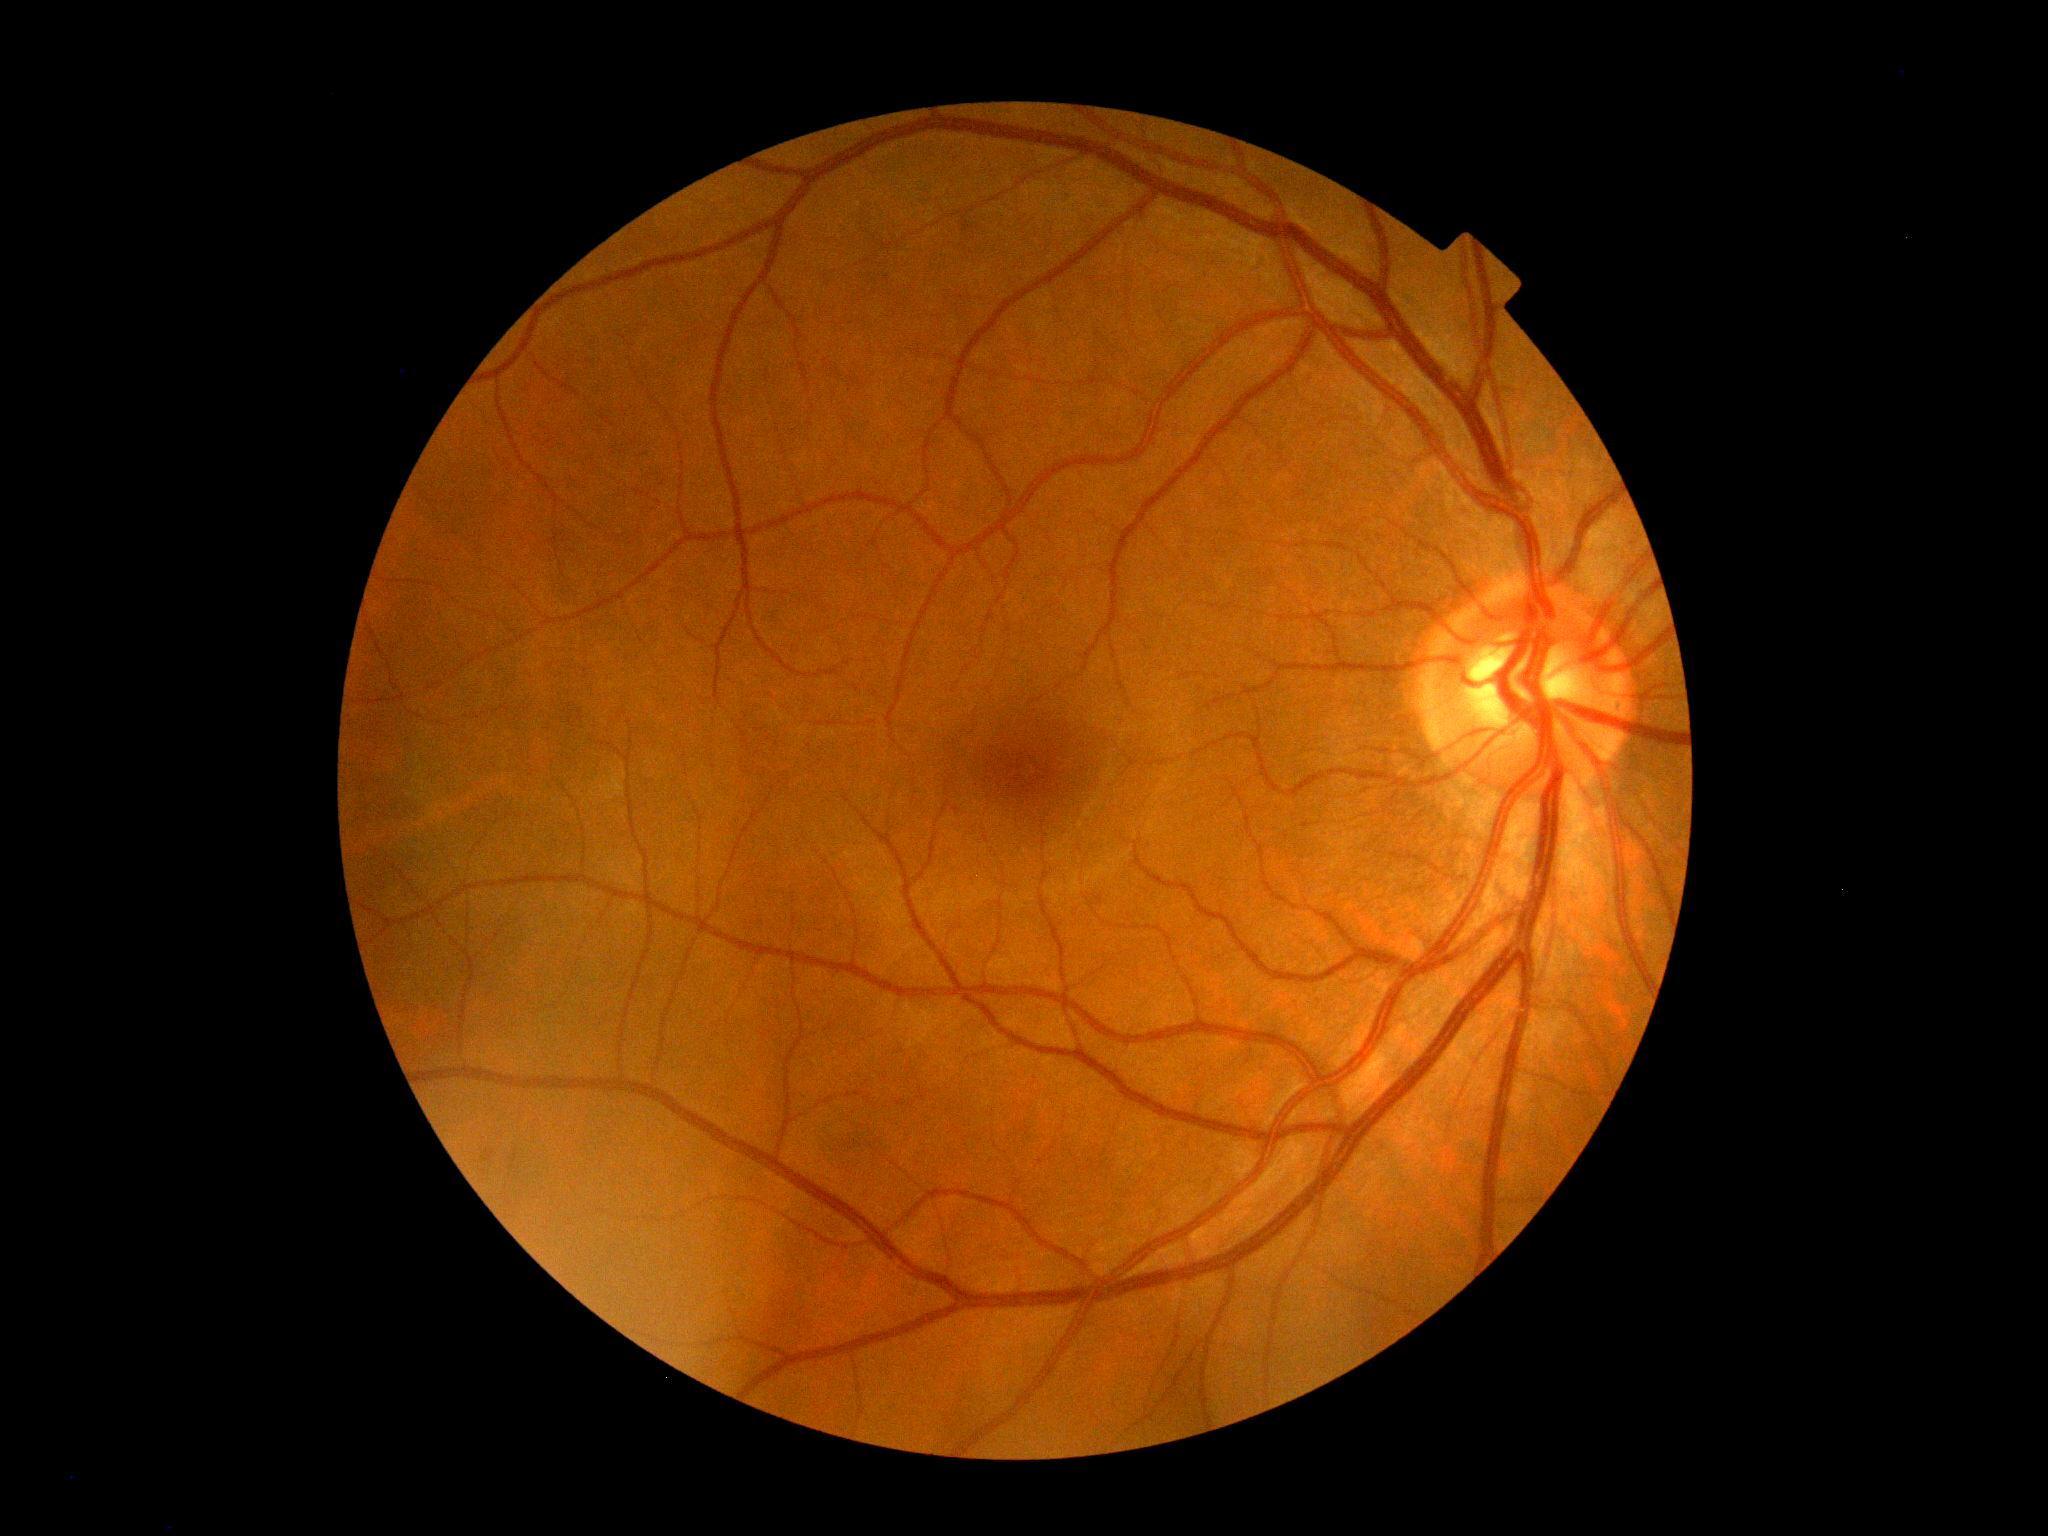

No DR findings.
Diabetic retinopathy (DR): 0/4.